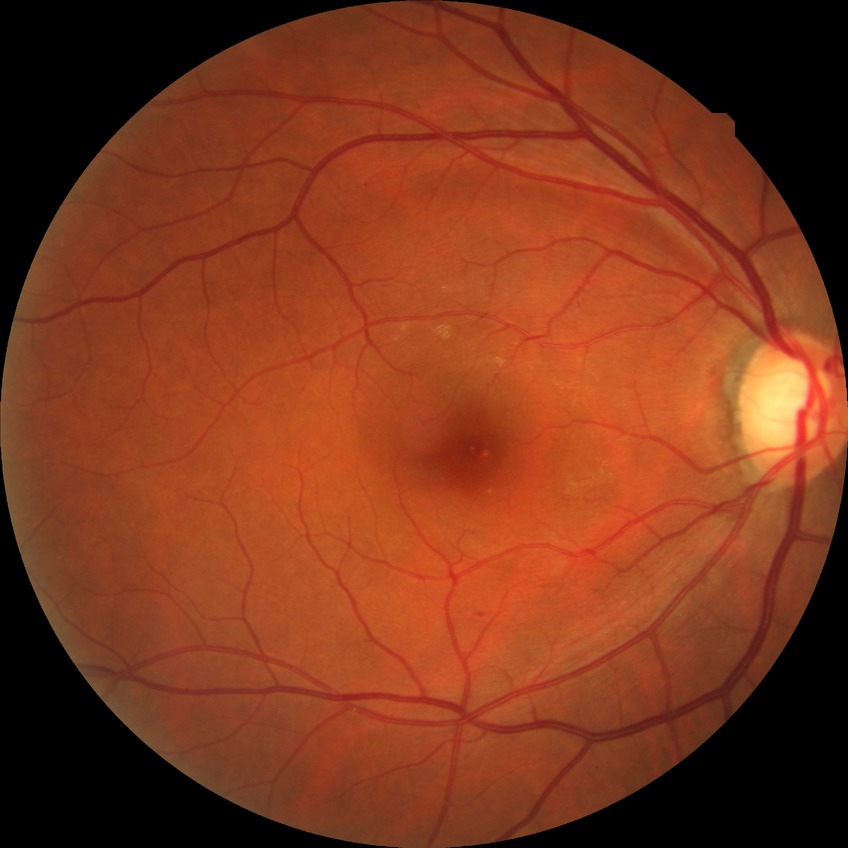
Davis DR grade is NDR.
No diabetic retinal disease findings.